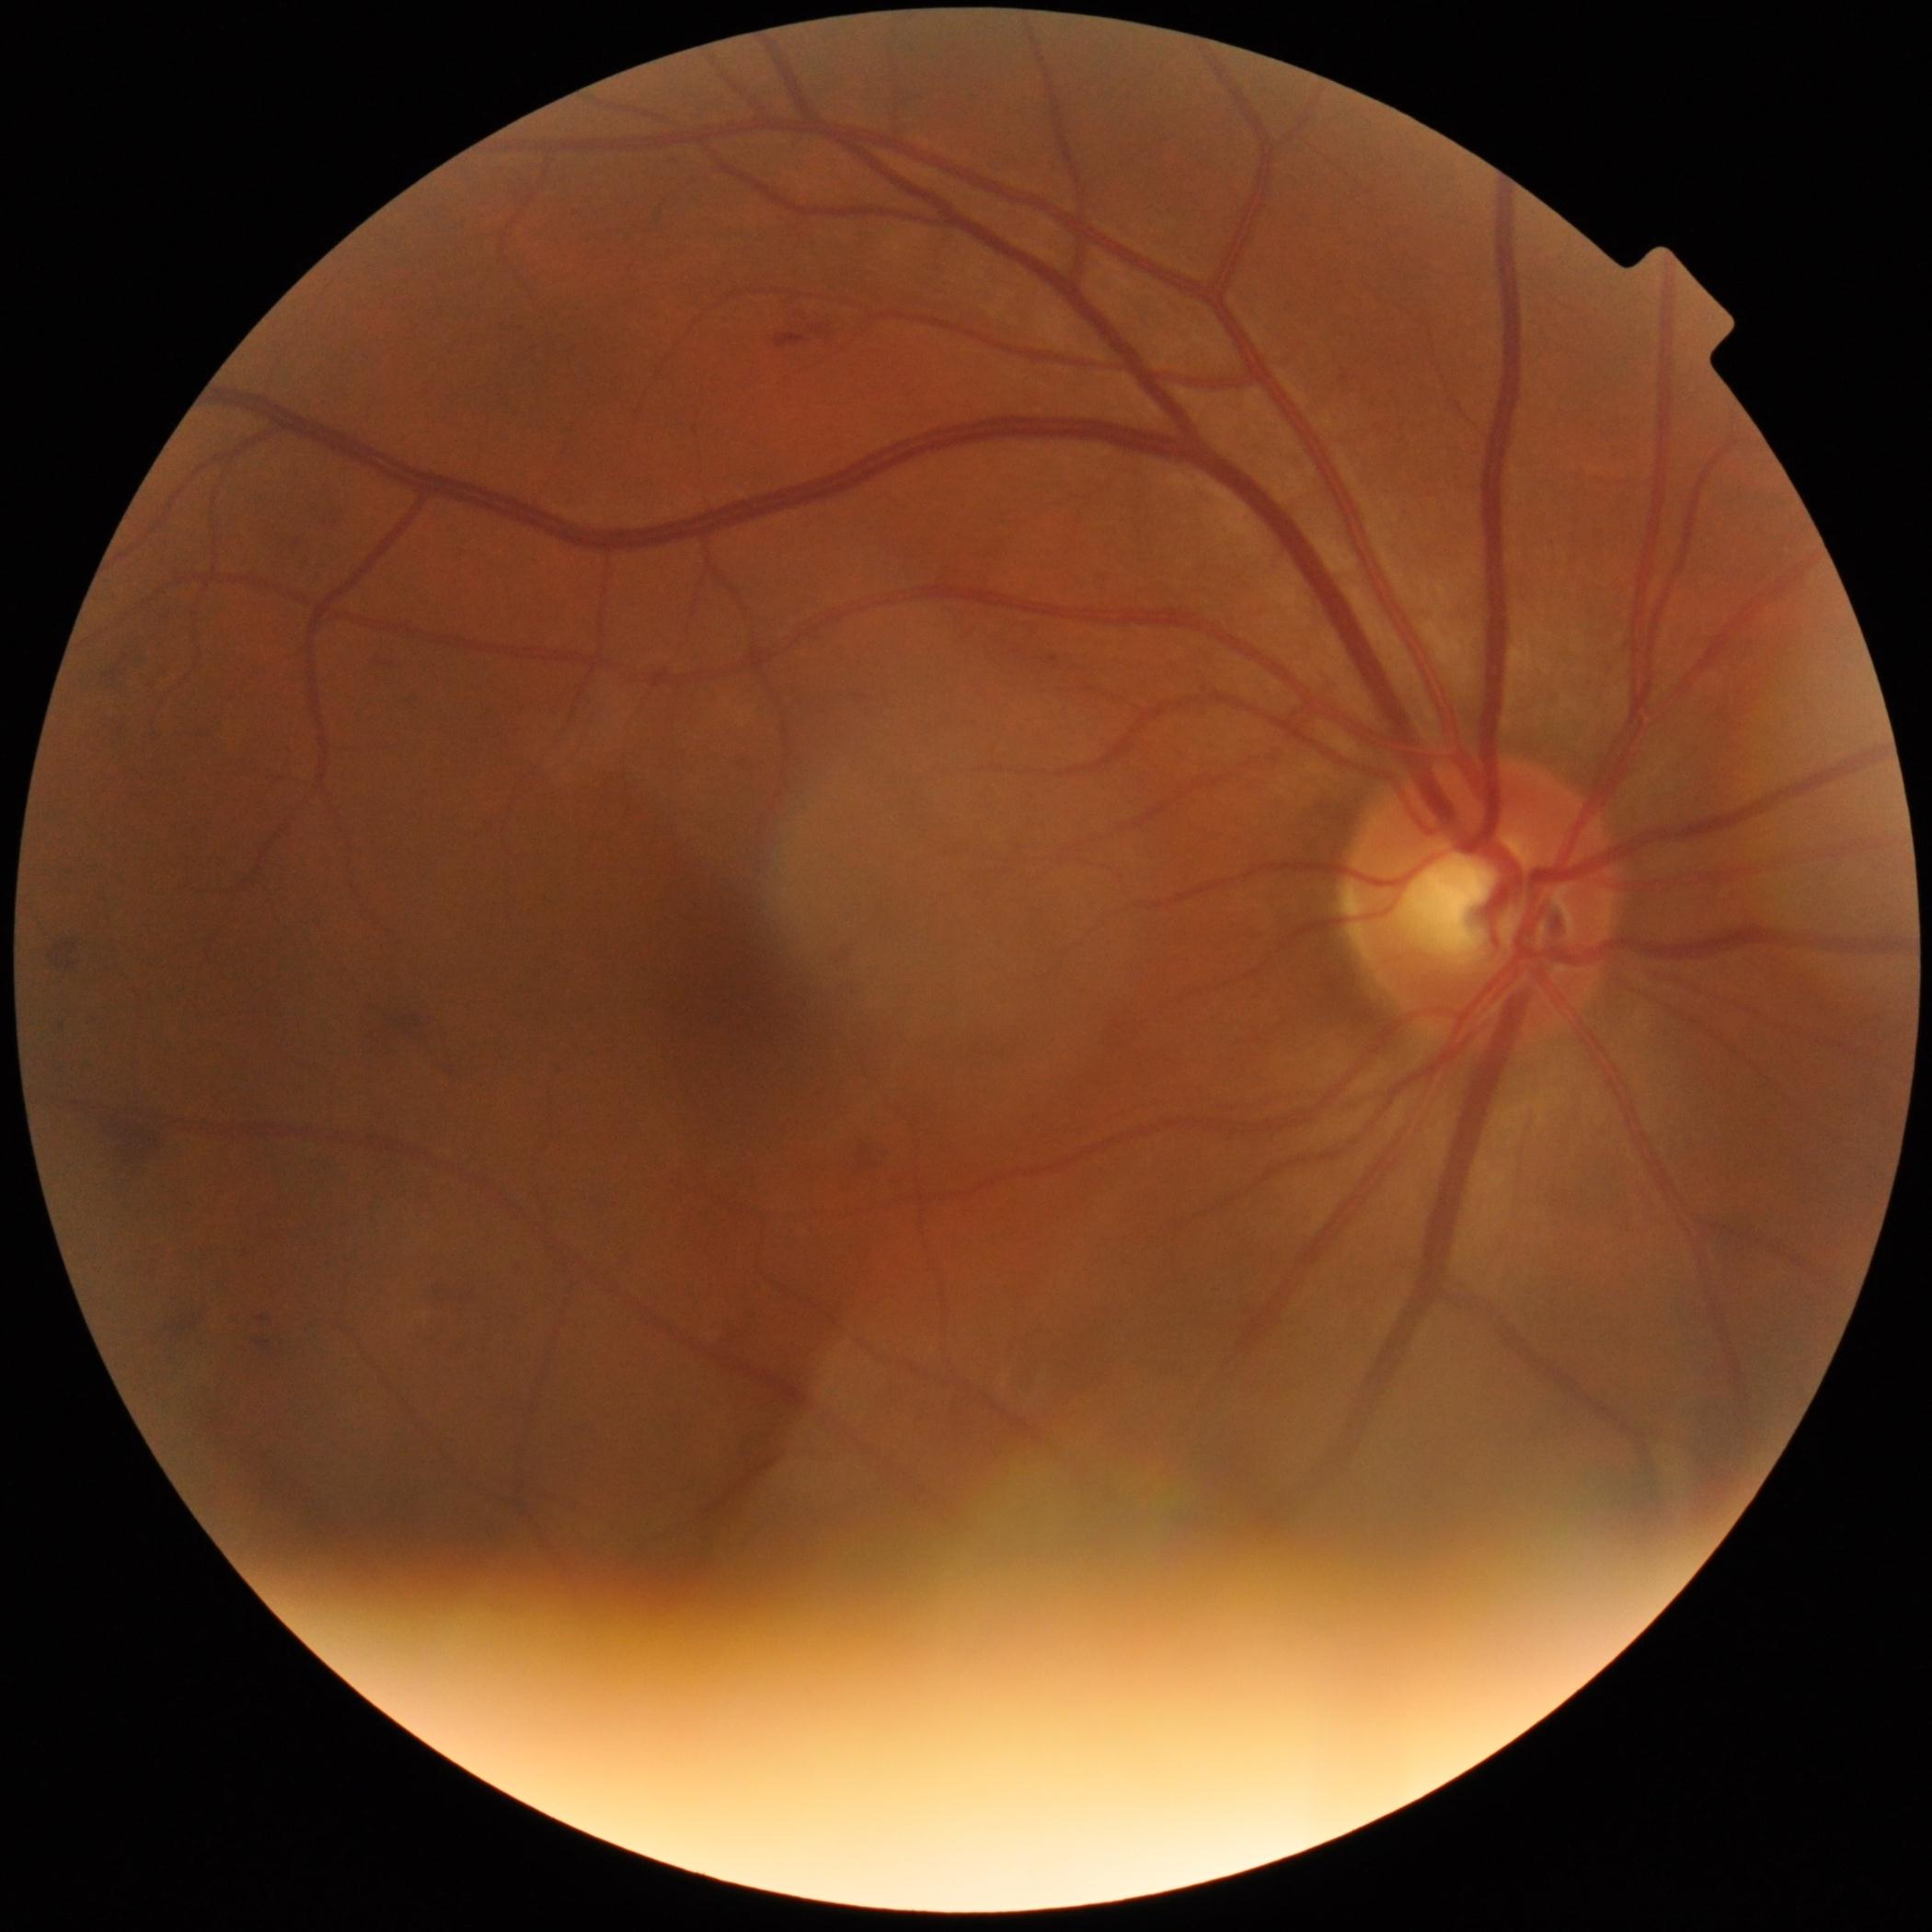

retinopathy=grade 2 (moderate NPDR).